Pediatric wide-field fundus photograph · 1240x1240.
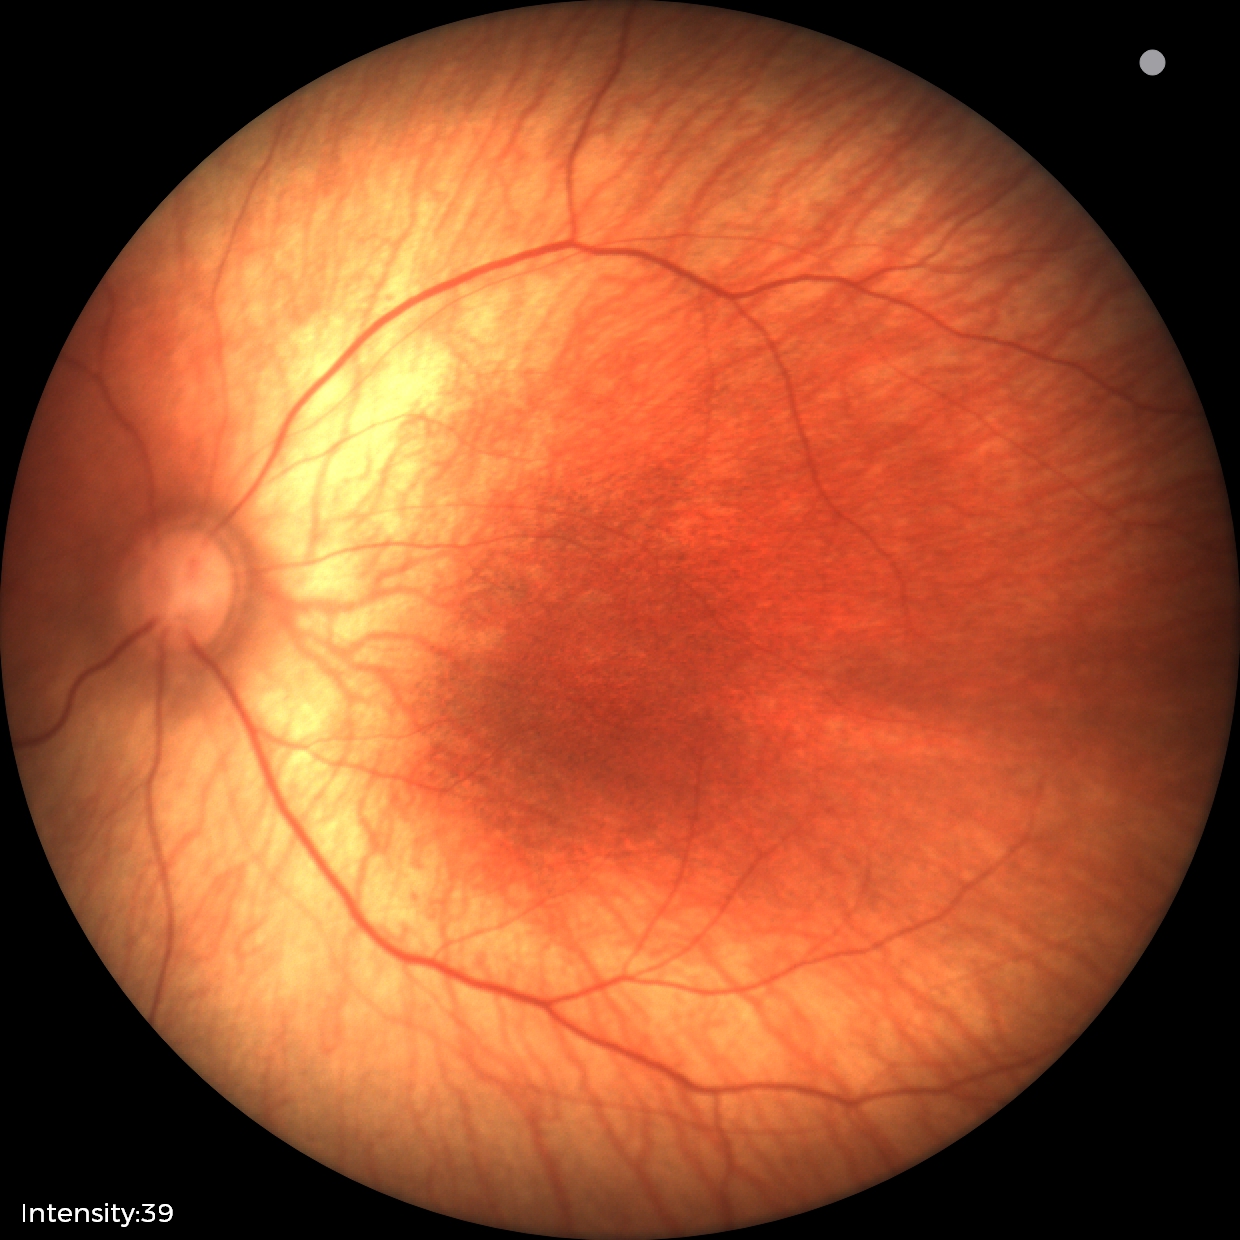 Screening examination diagnosed as physiological.